848x848, camera: NIDEK AFC-230, FOV: 45 degrees, nonmydriatic fundus photograph, DR severity per modified Davis staging:
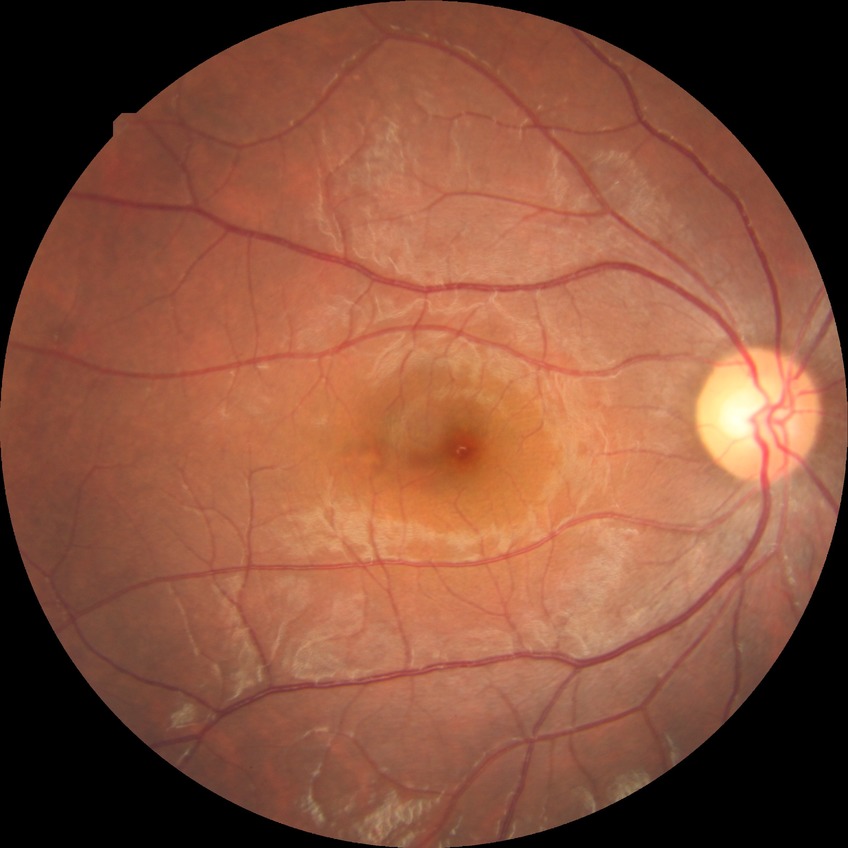
retinopathy stage = no diabetic retinopathy.